CFP — 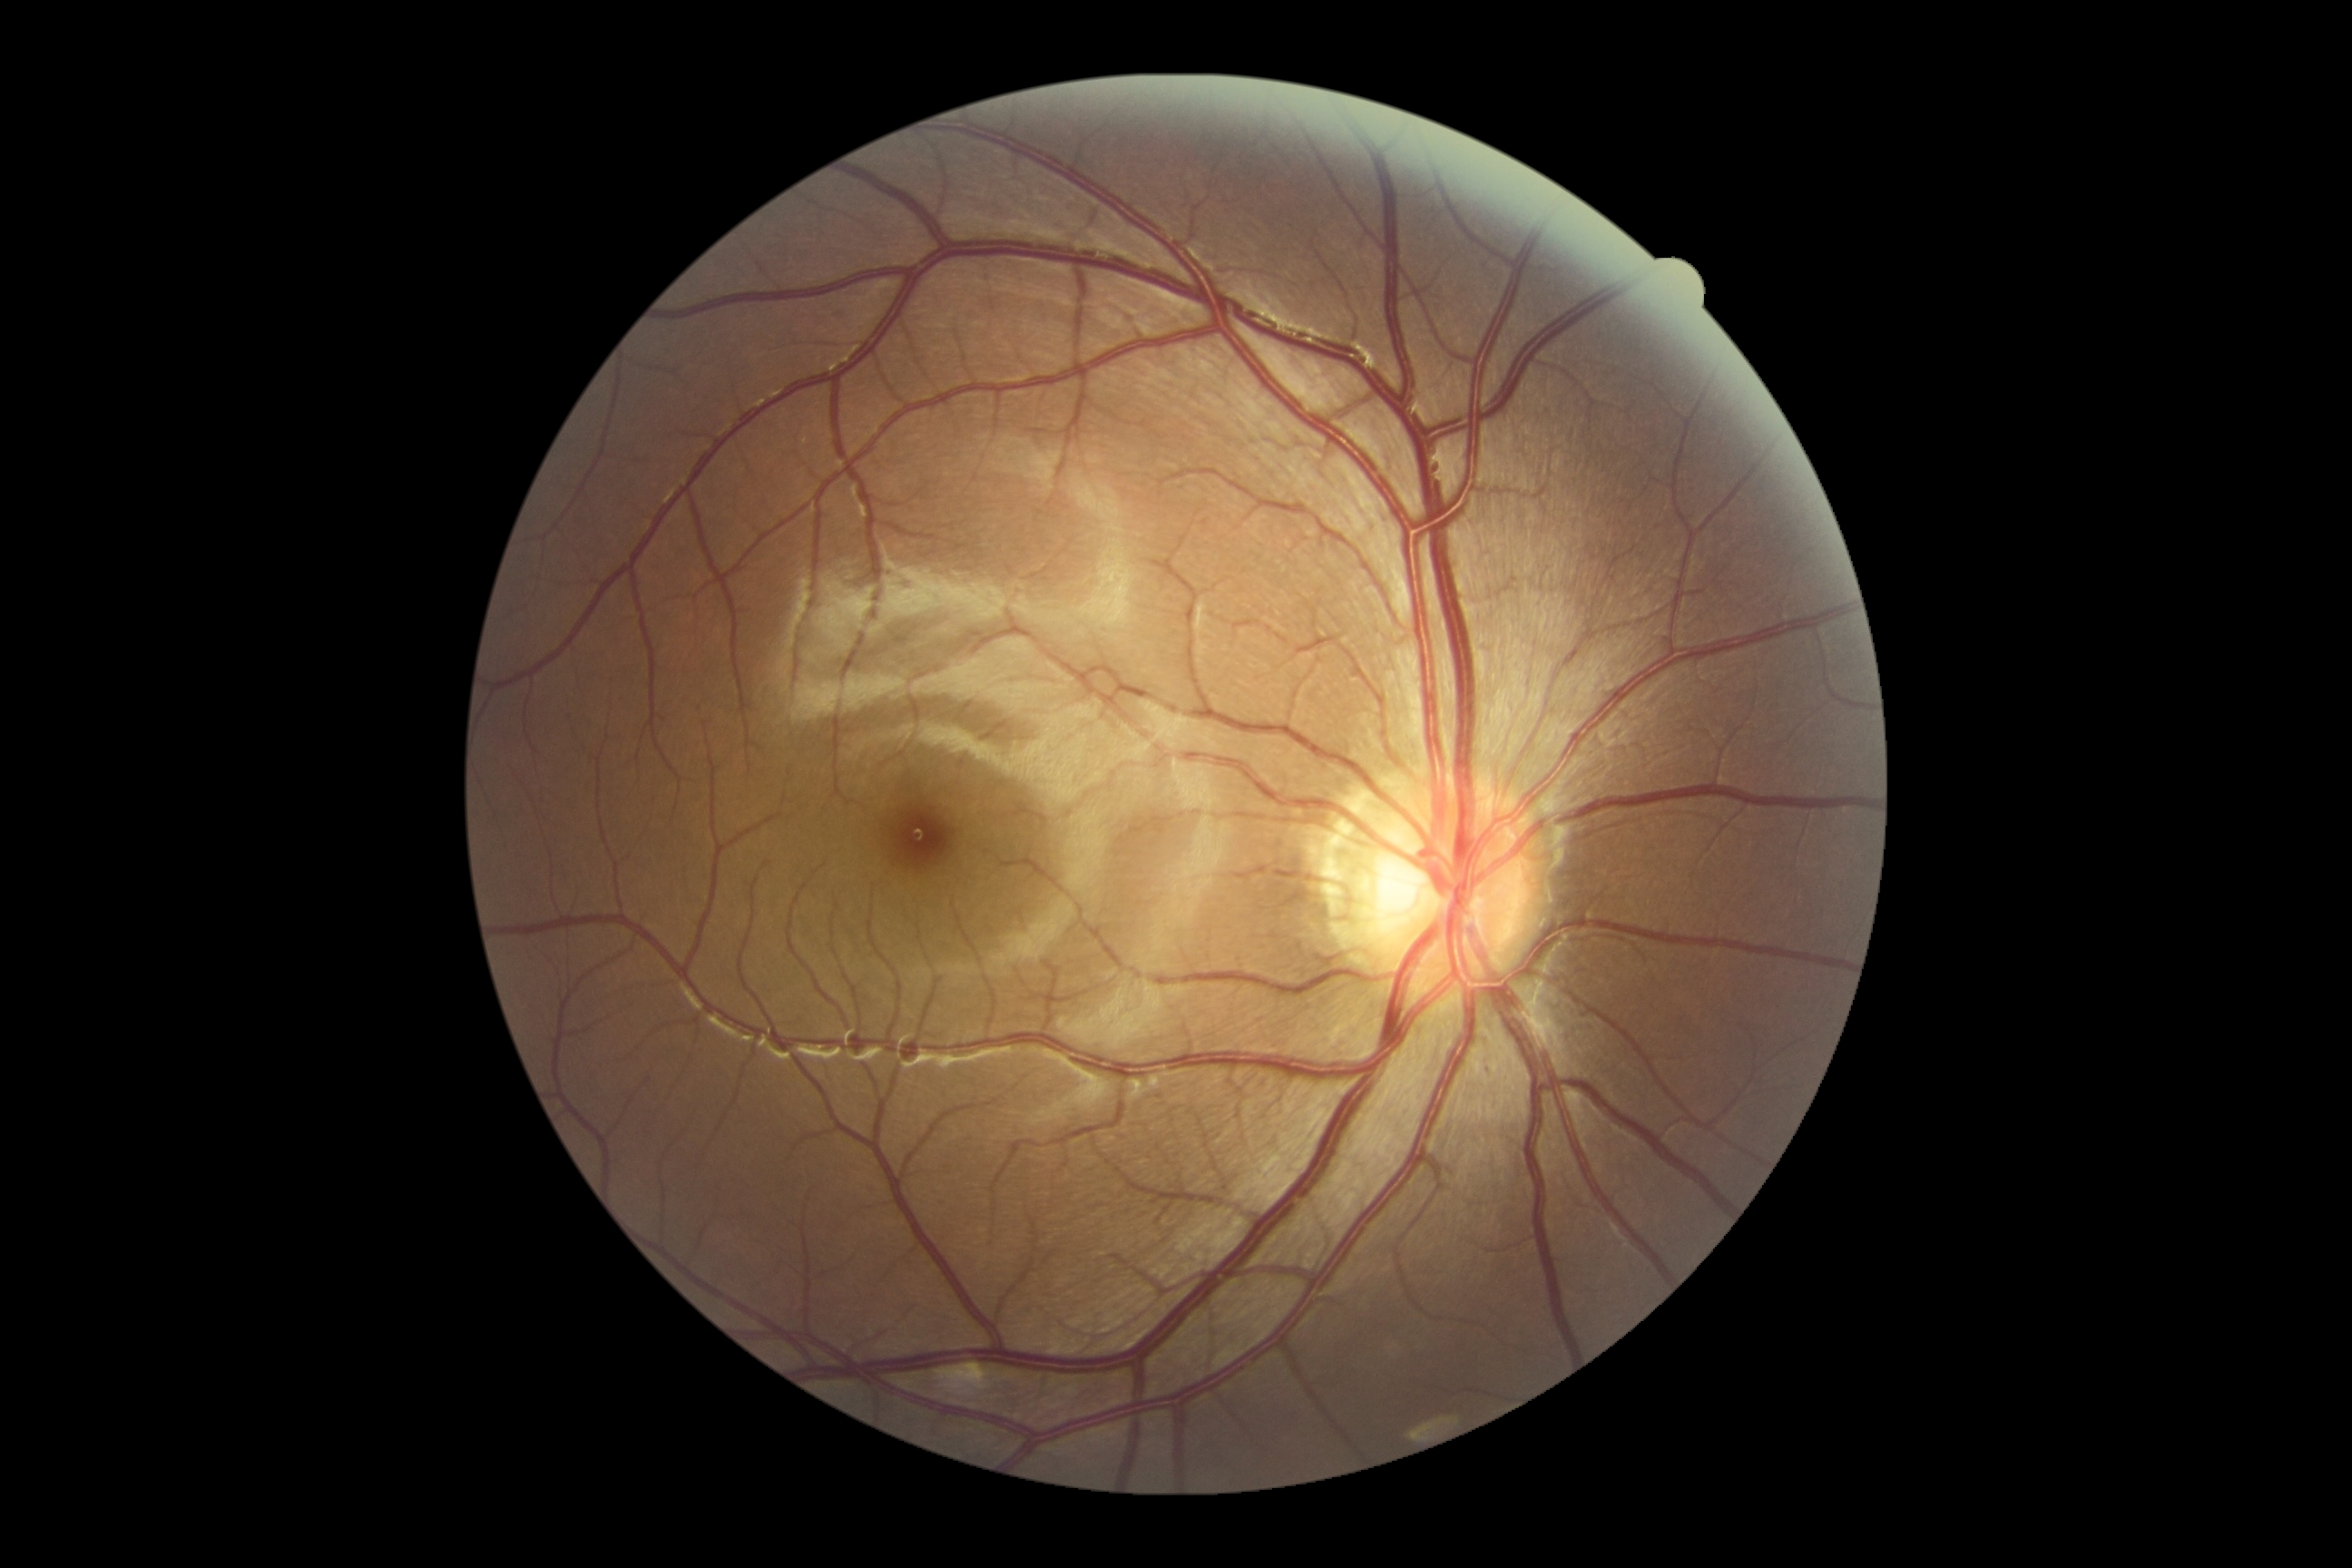
Diabetic retinopathy (DR): grade 0. No apparent diabetic retinopathy.